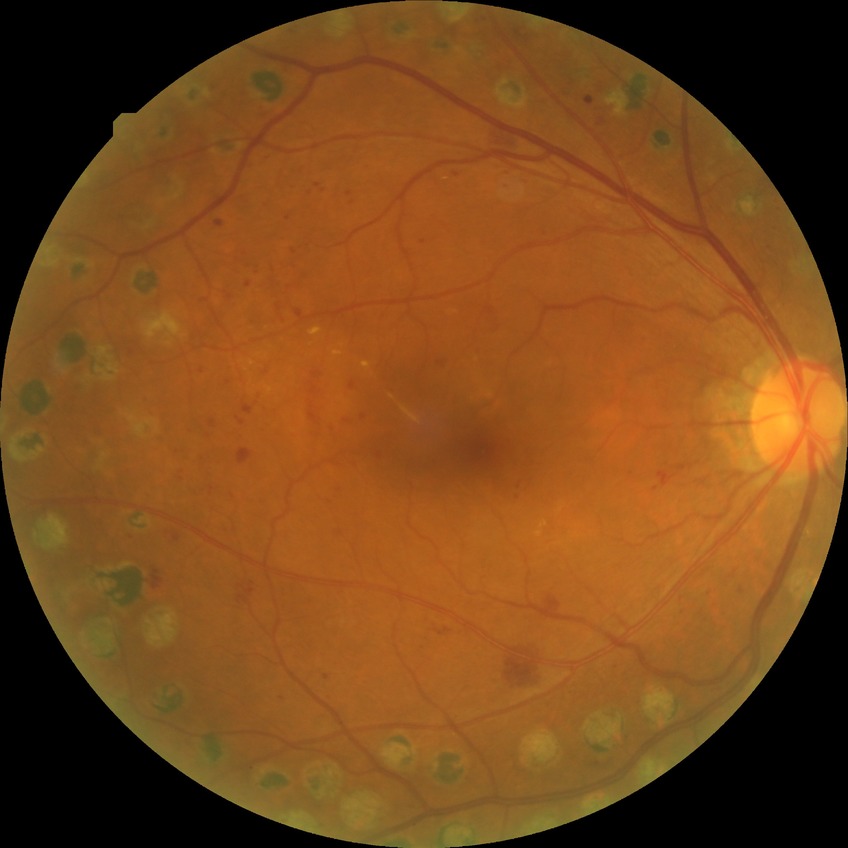

modified Davis classification@proliferative diabetic retinopathy.